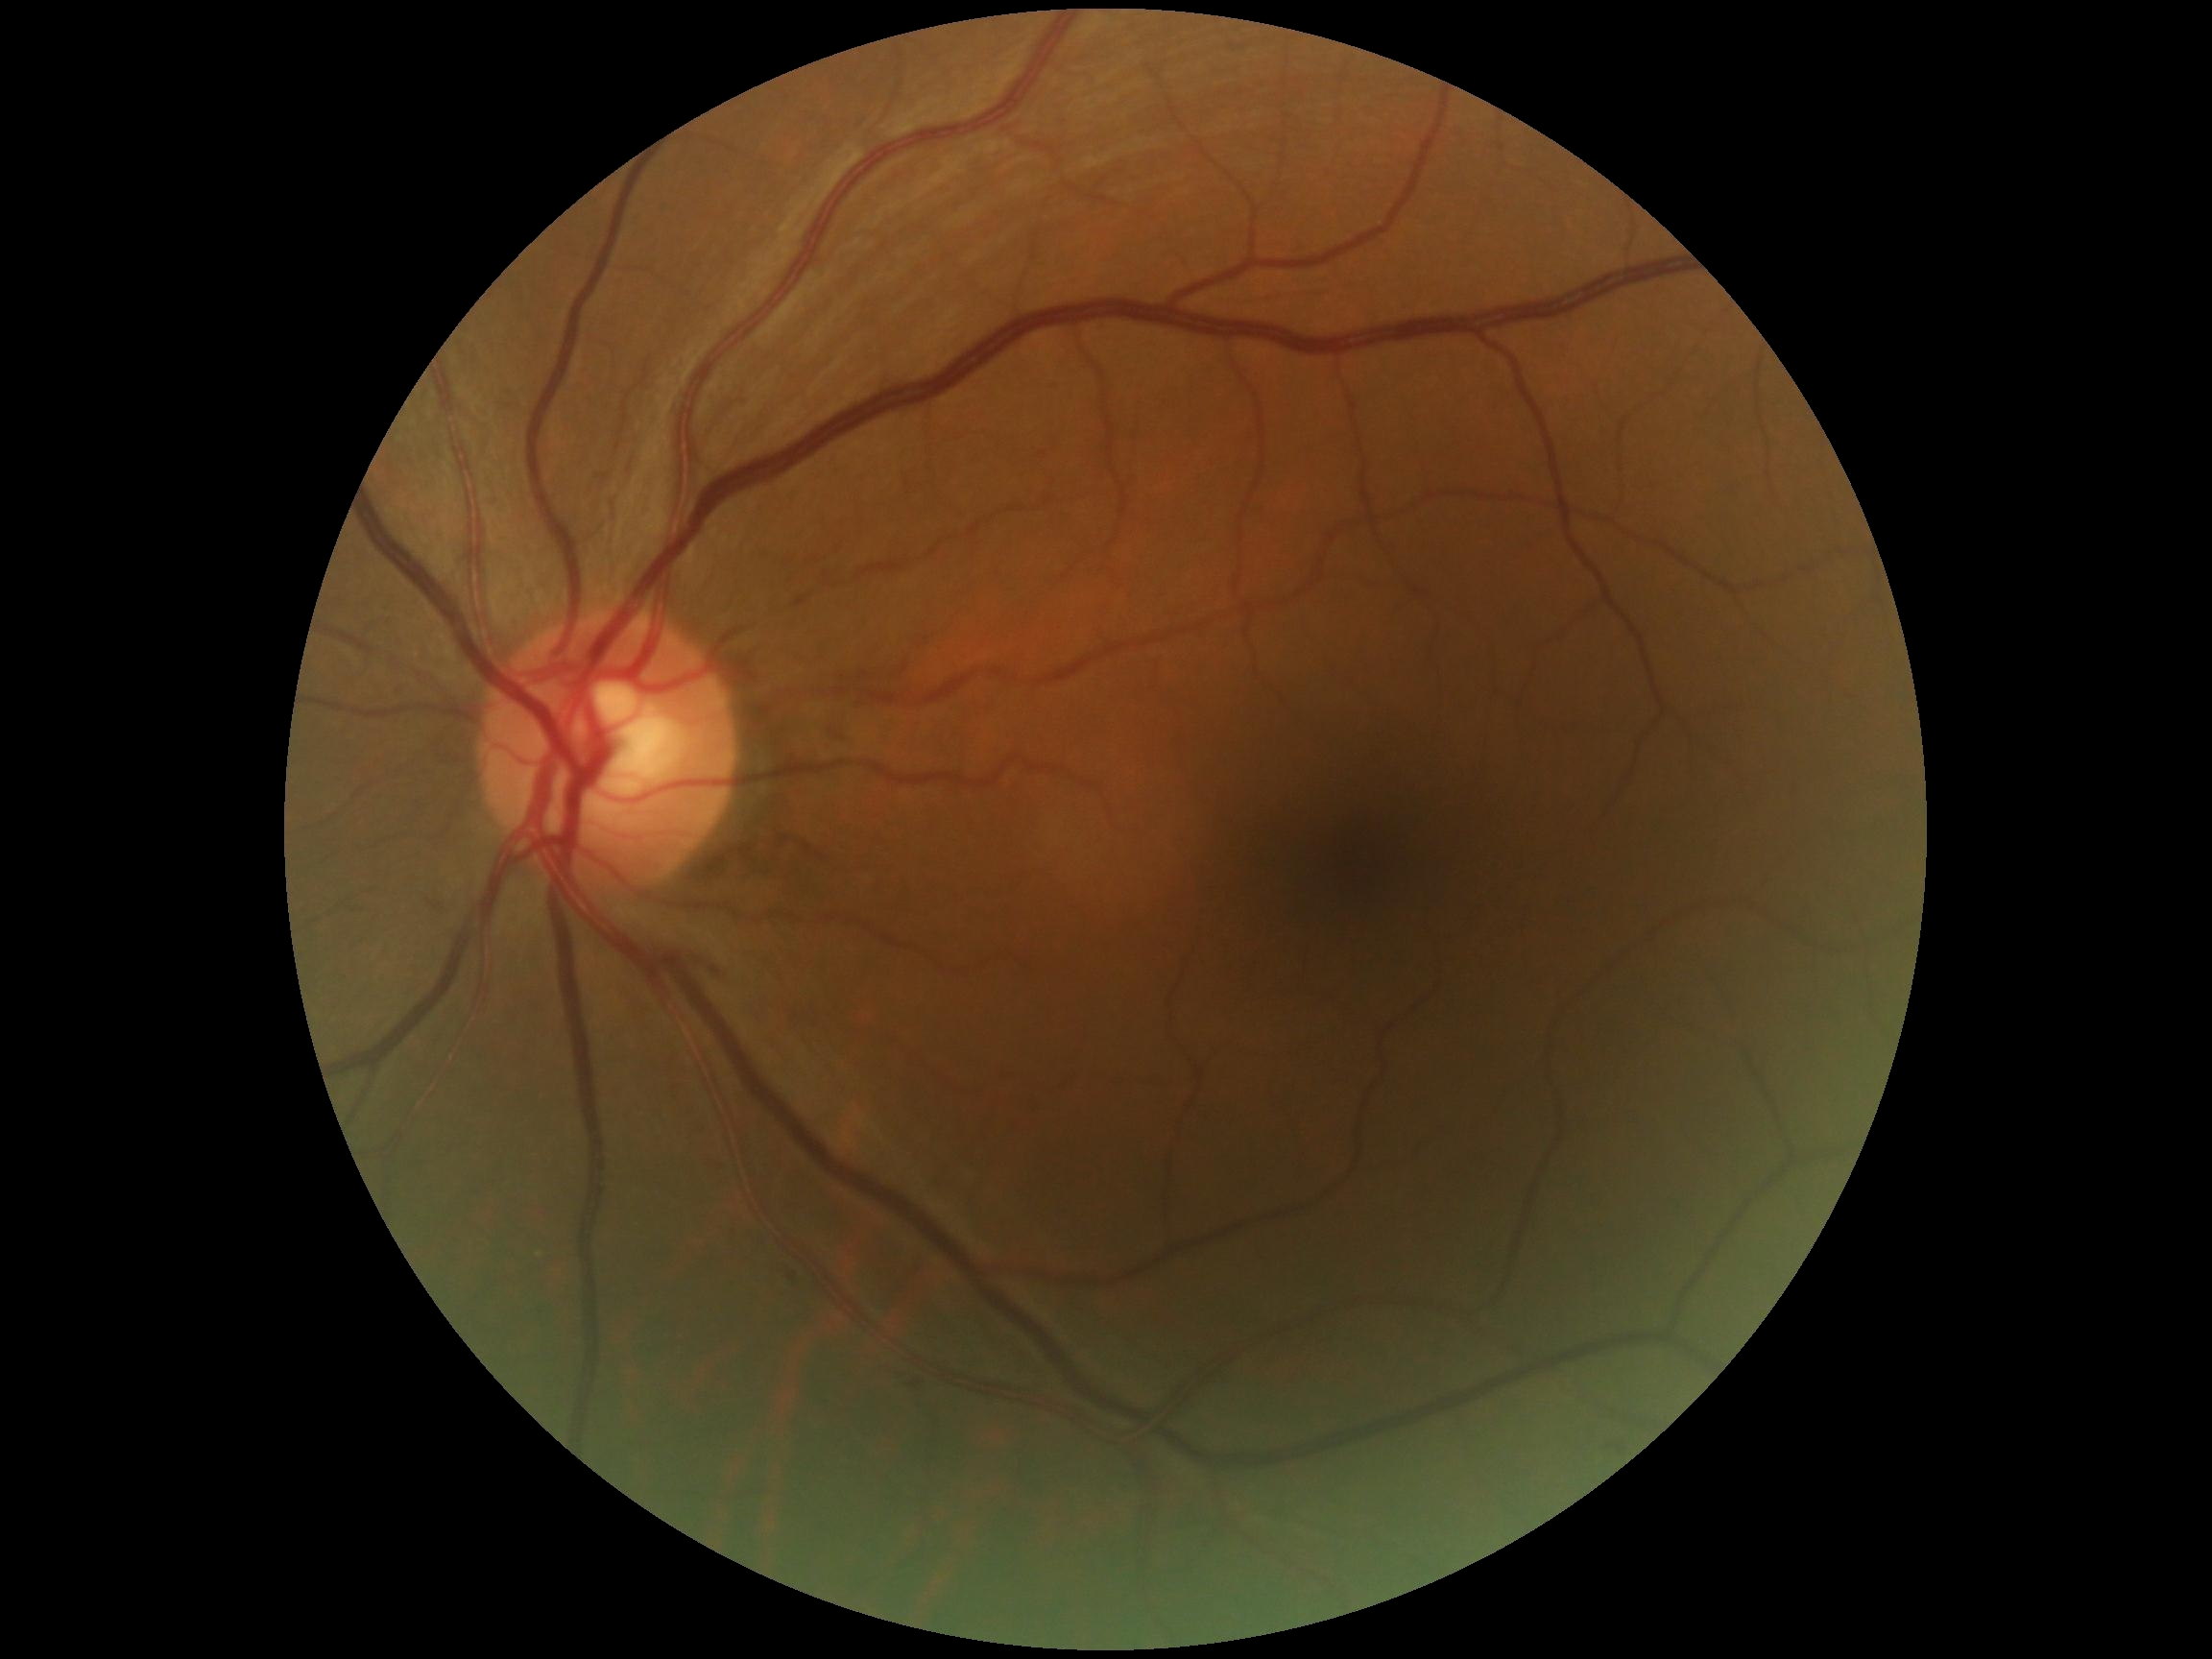 Diabetic retinopathy grade is 0/4.